Infant wide-field fundus photograph:
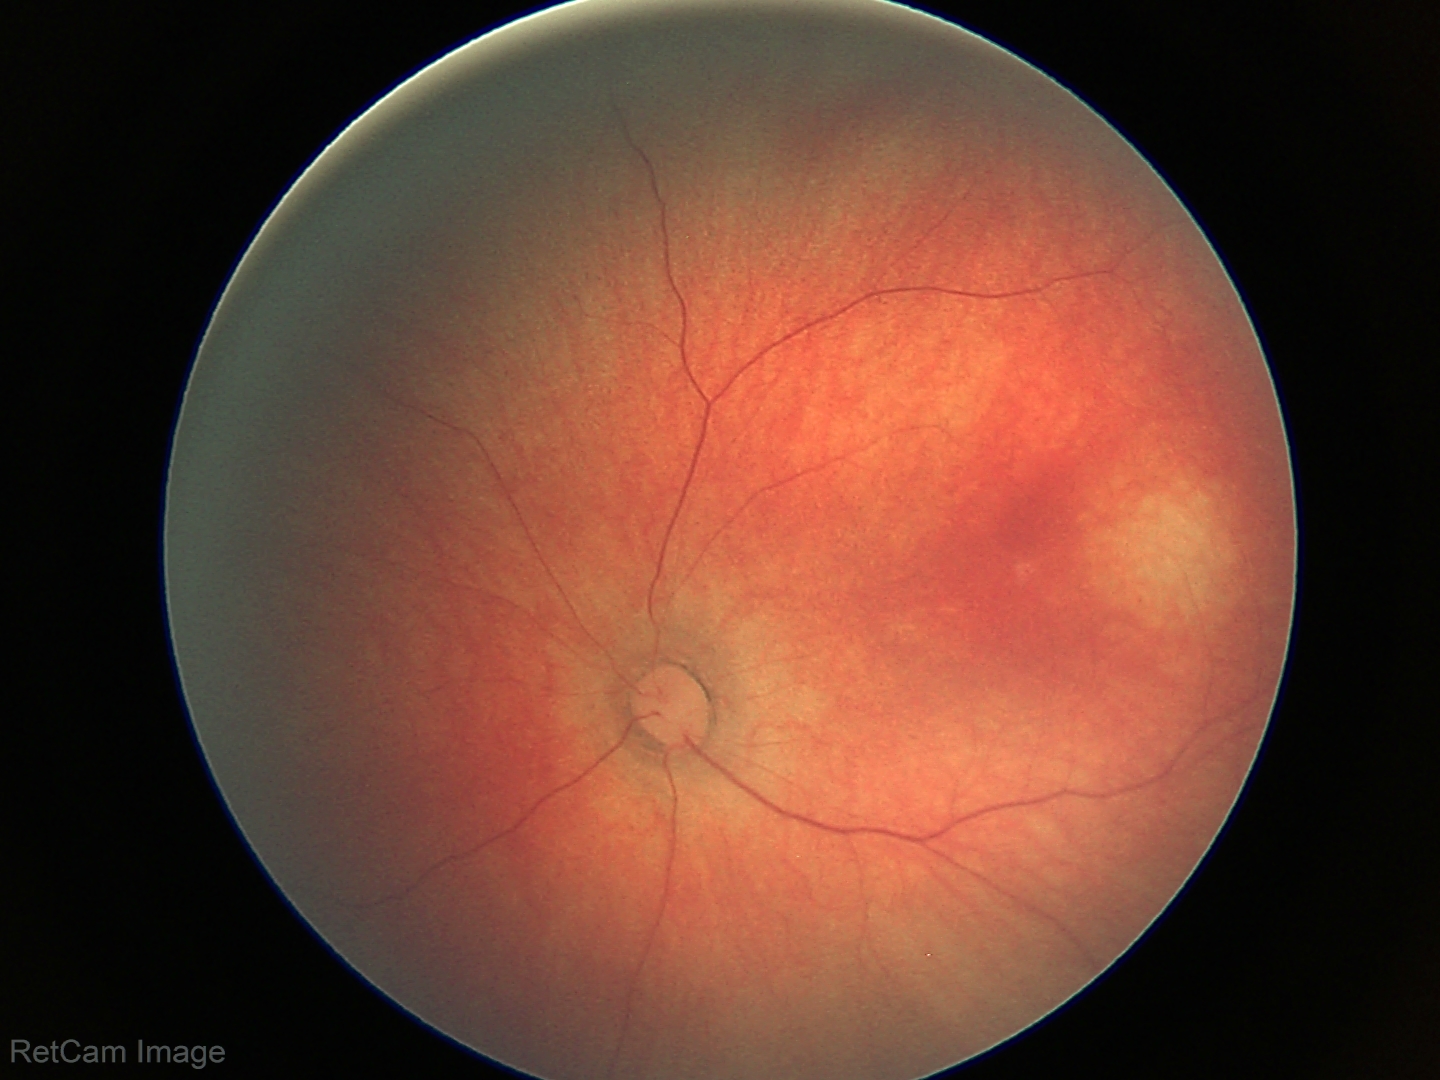
Examination with physiological retinal findings.